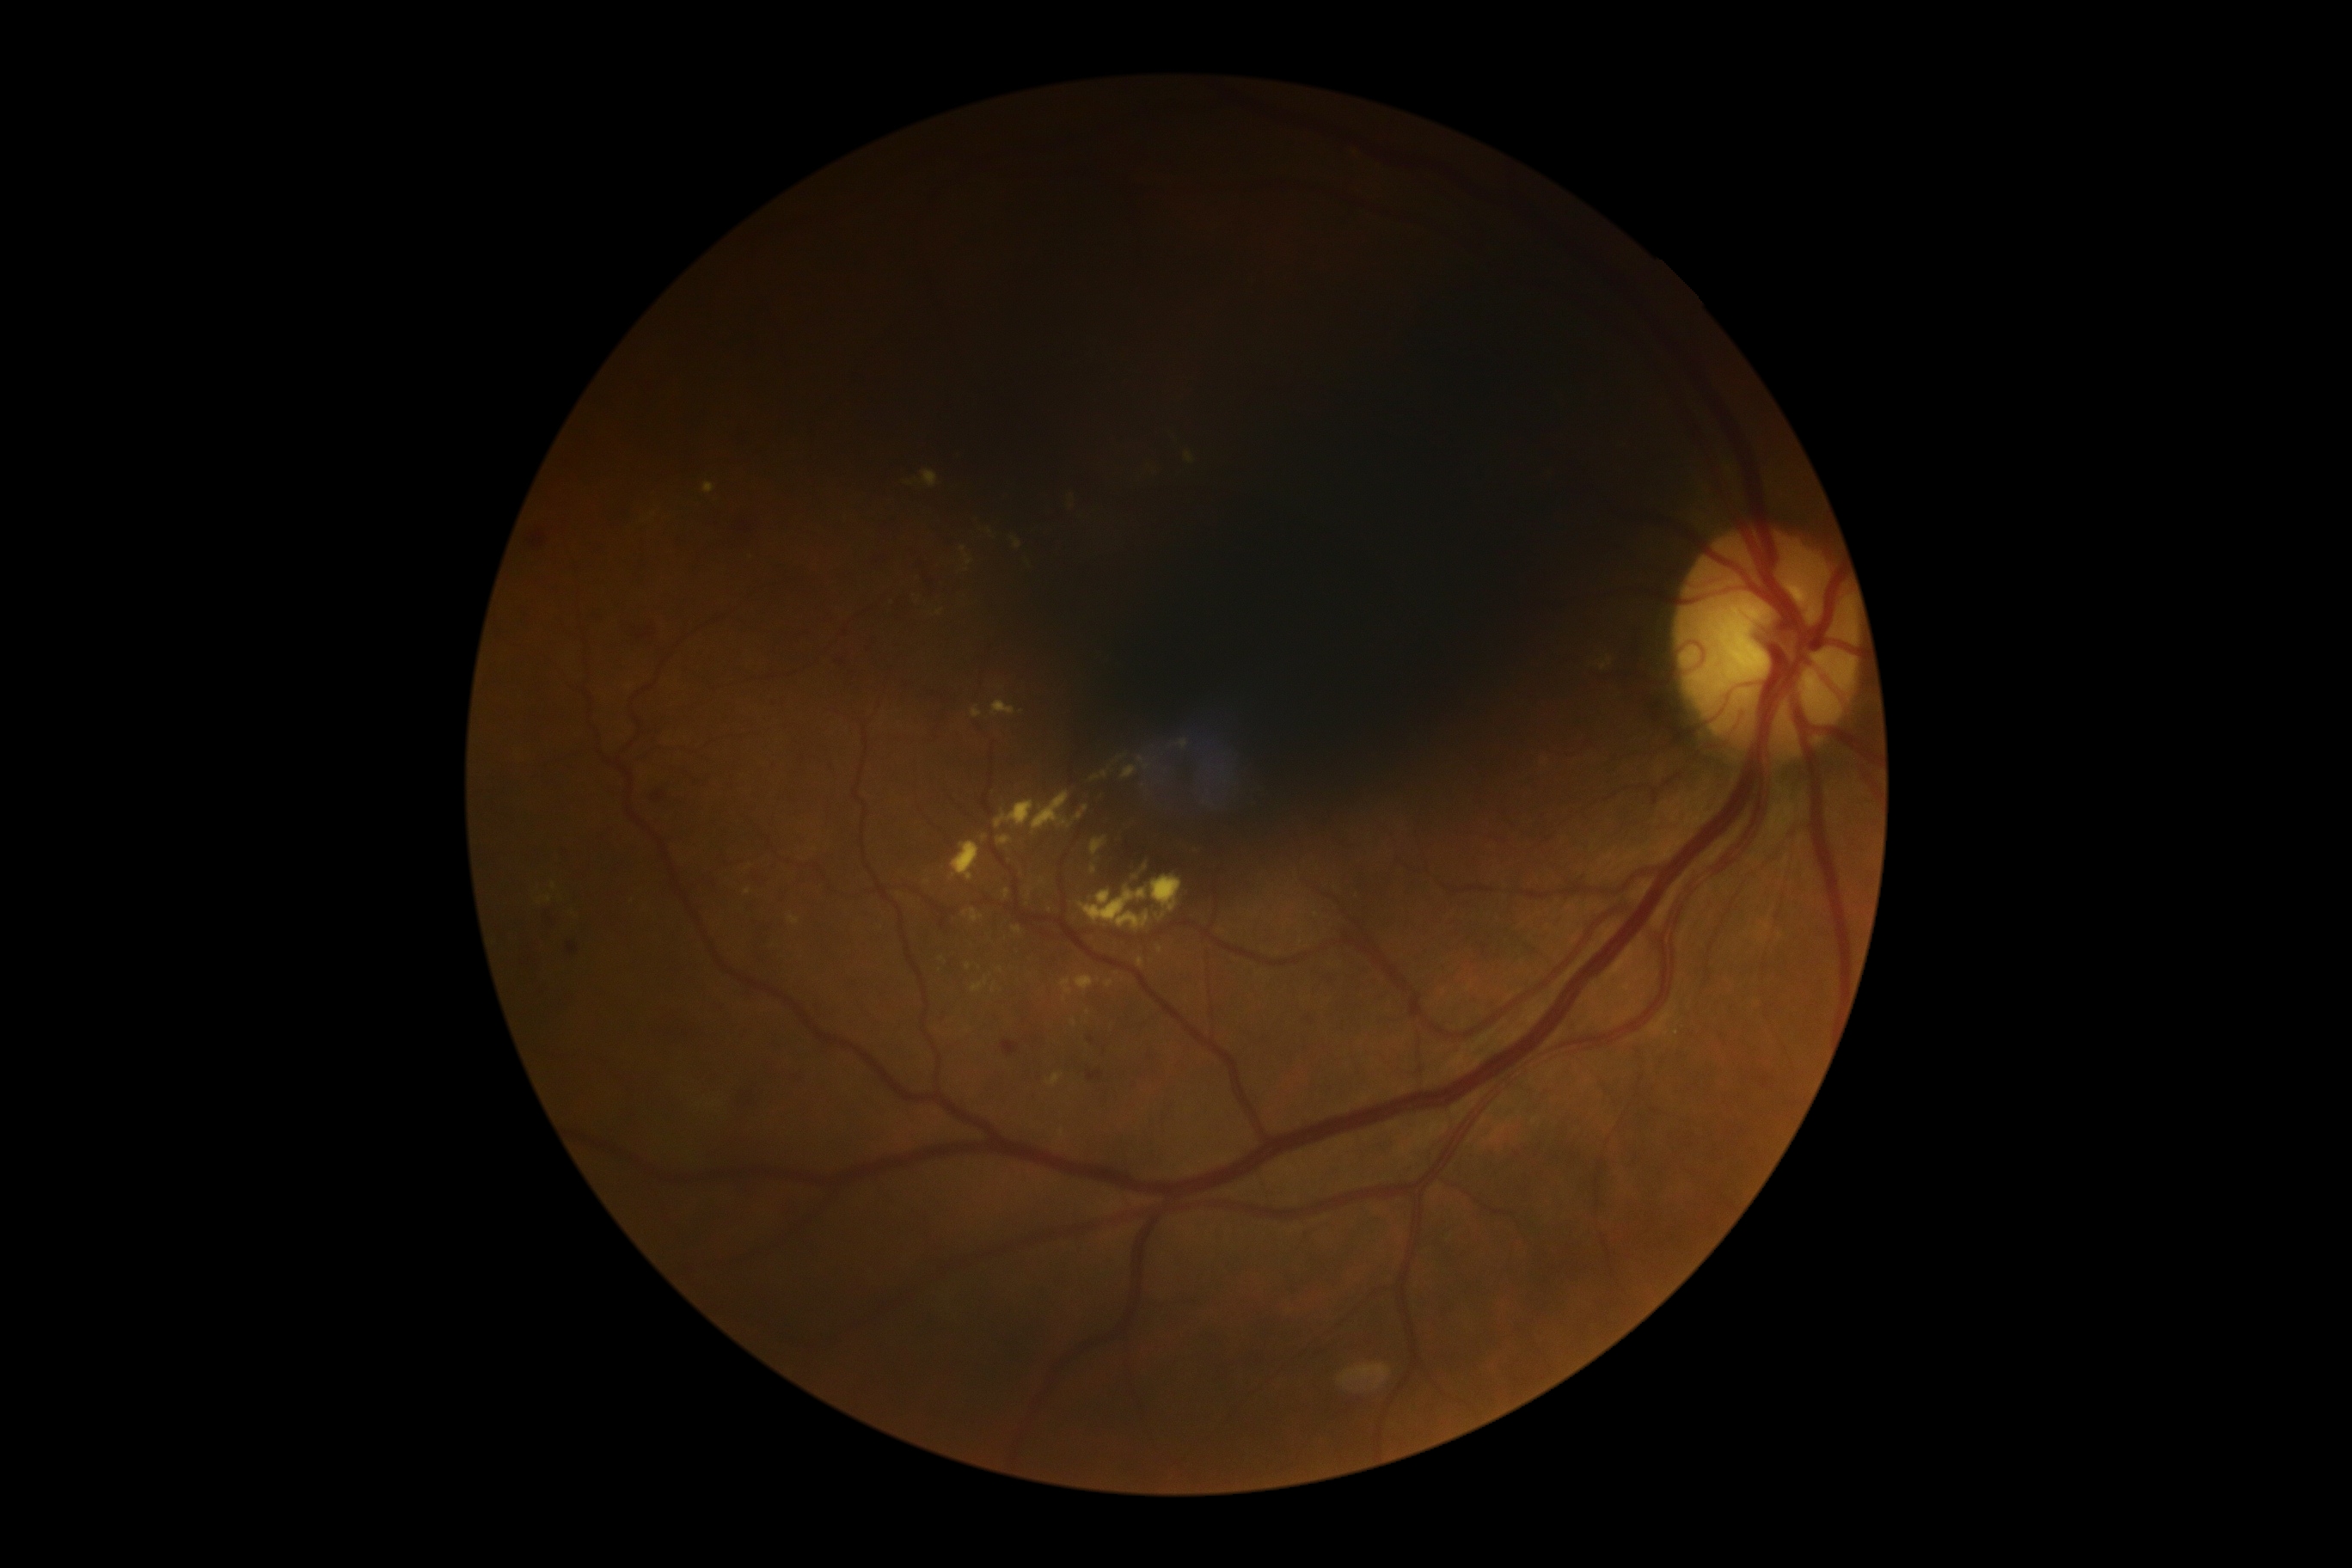

The retinopathy is classified as non-proliferative diabetic retinopathy.
Retinopathy is 2/4.